200° FOV · 1924x1556:
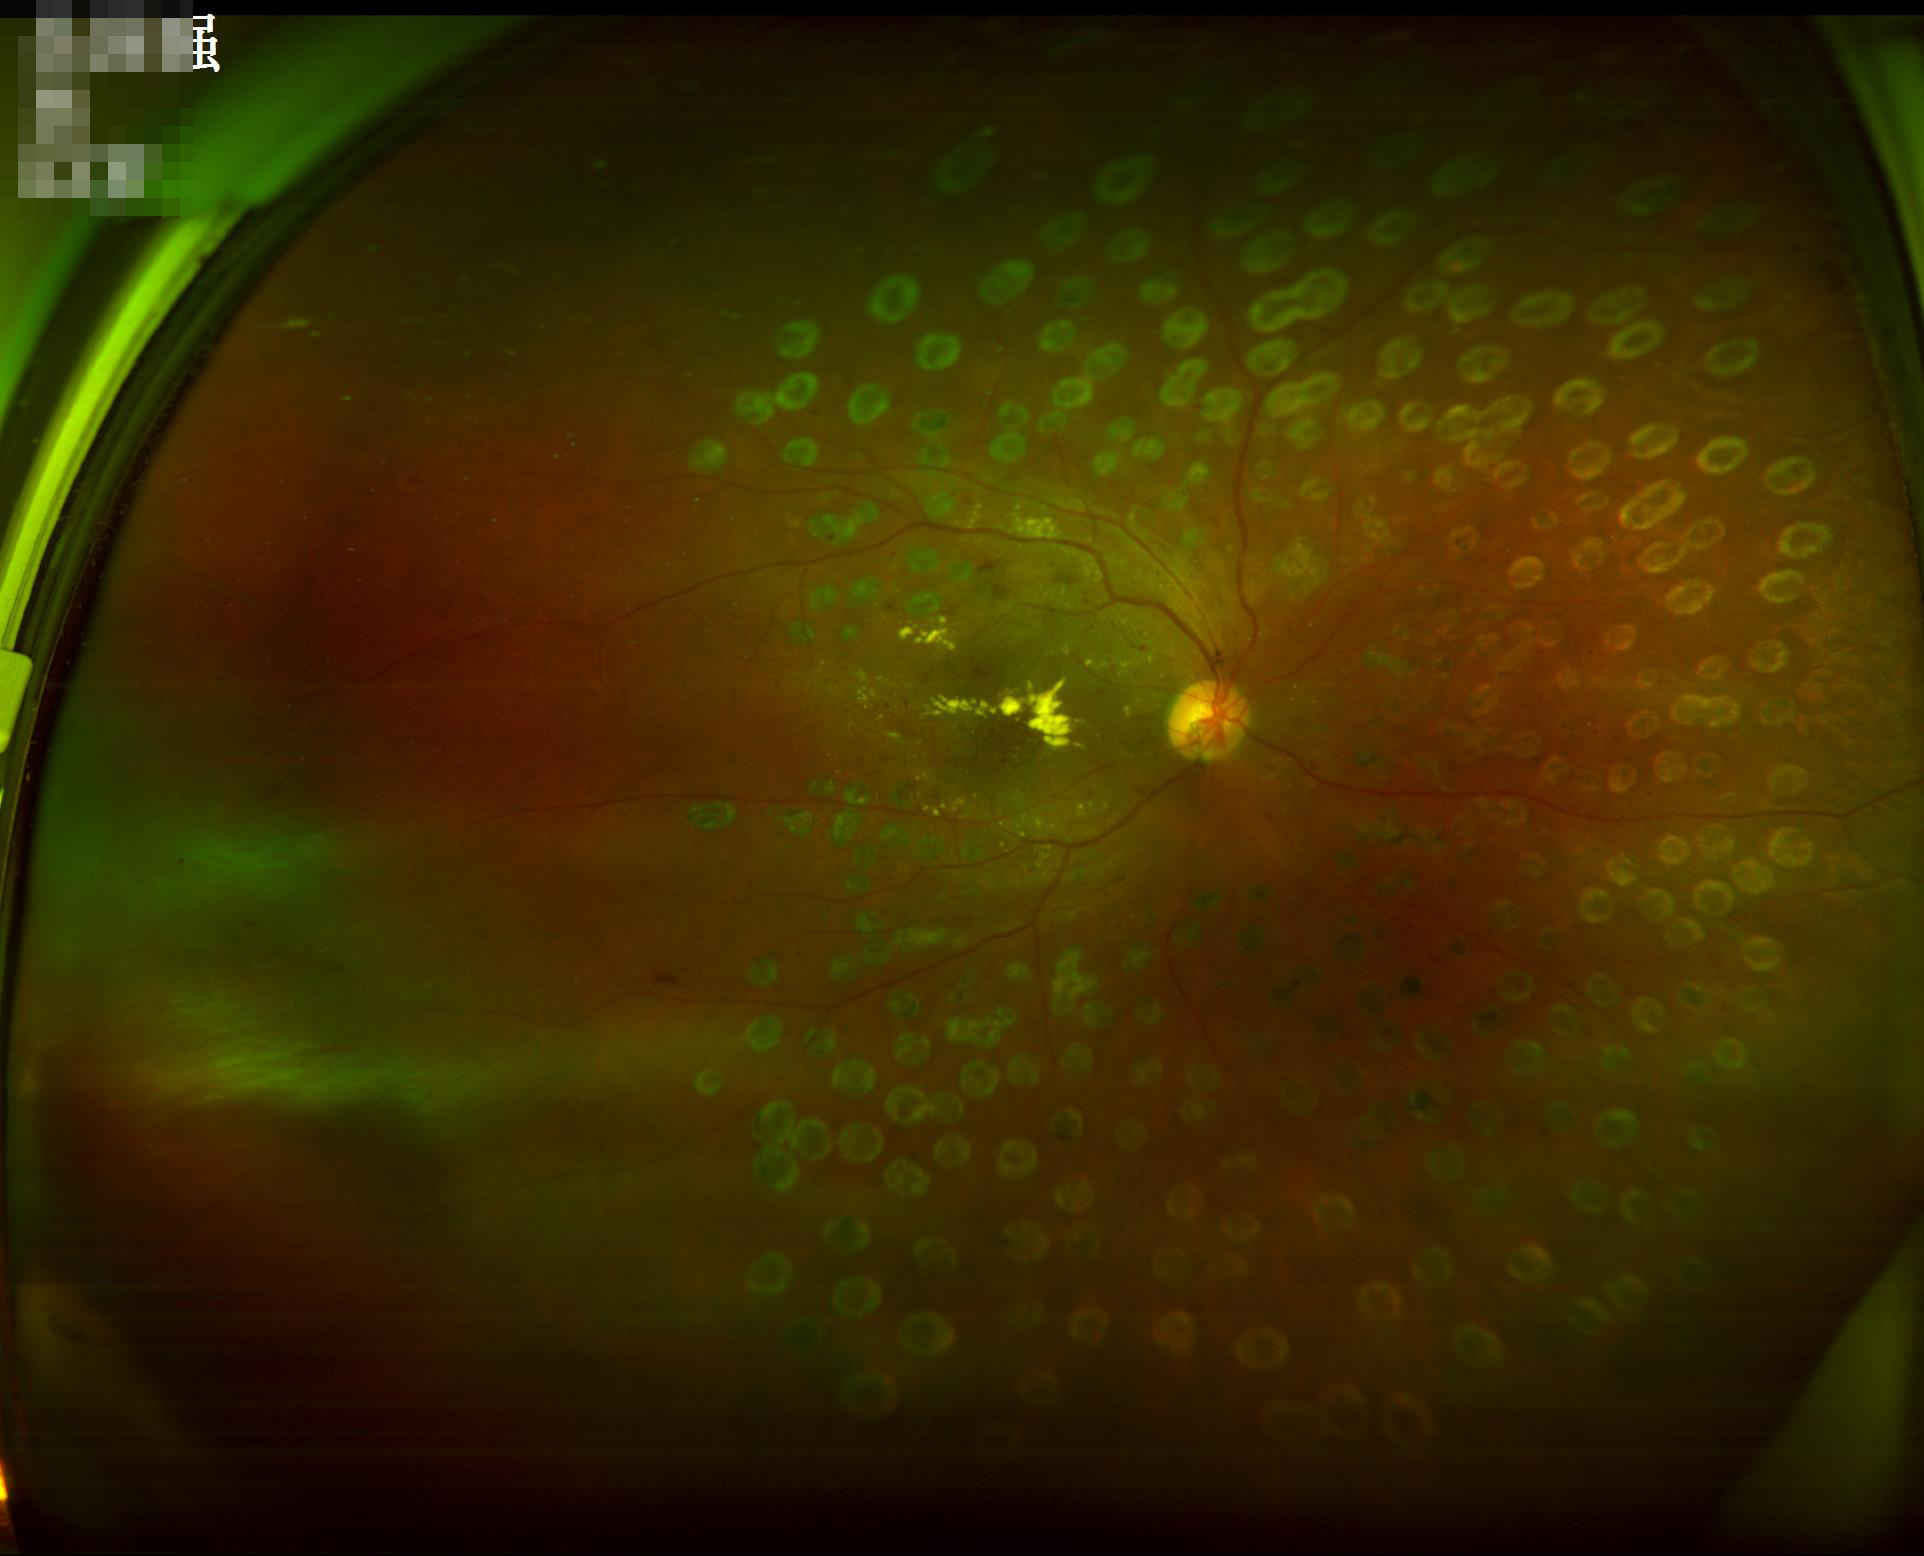
Overall quality is good and the image is gradable. Even illumination with no color cast. The image is blurry.